640 x 480 pixels. Pediatric wide-field fundus photograph: 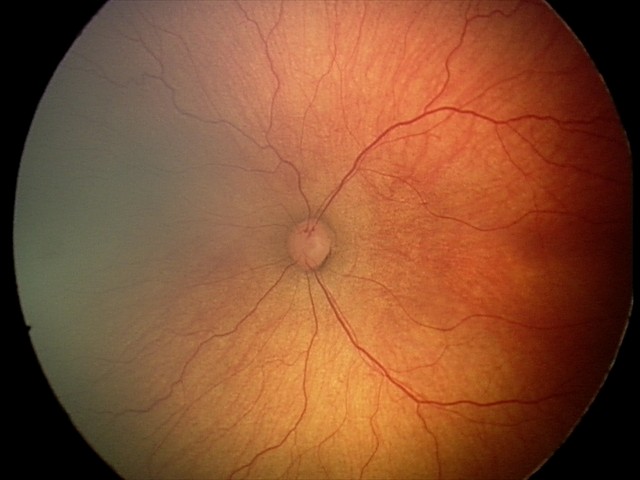
Assessment: retinopathy of prematurity (ROP) stage 2.